Fundus photo, 1932x1910px, 45-degree field of view
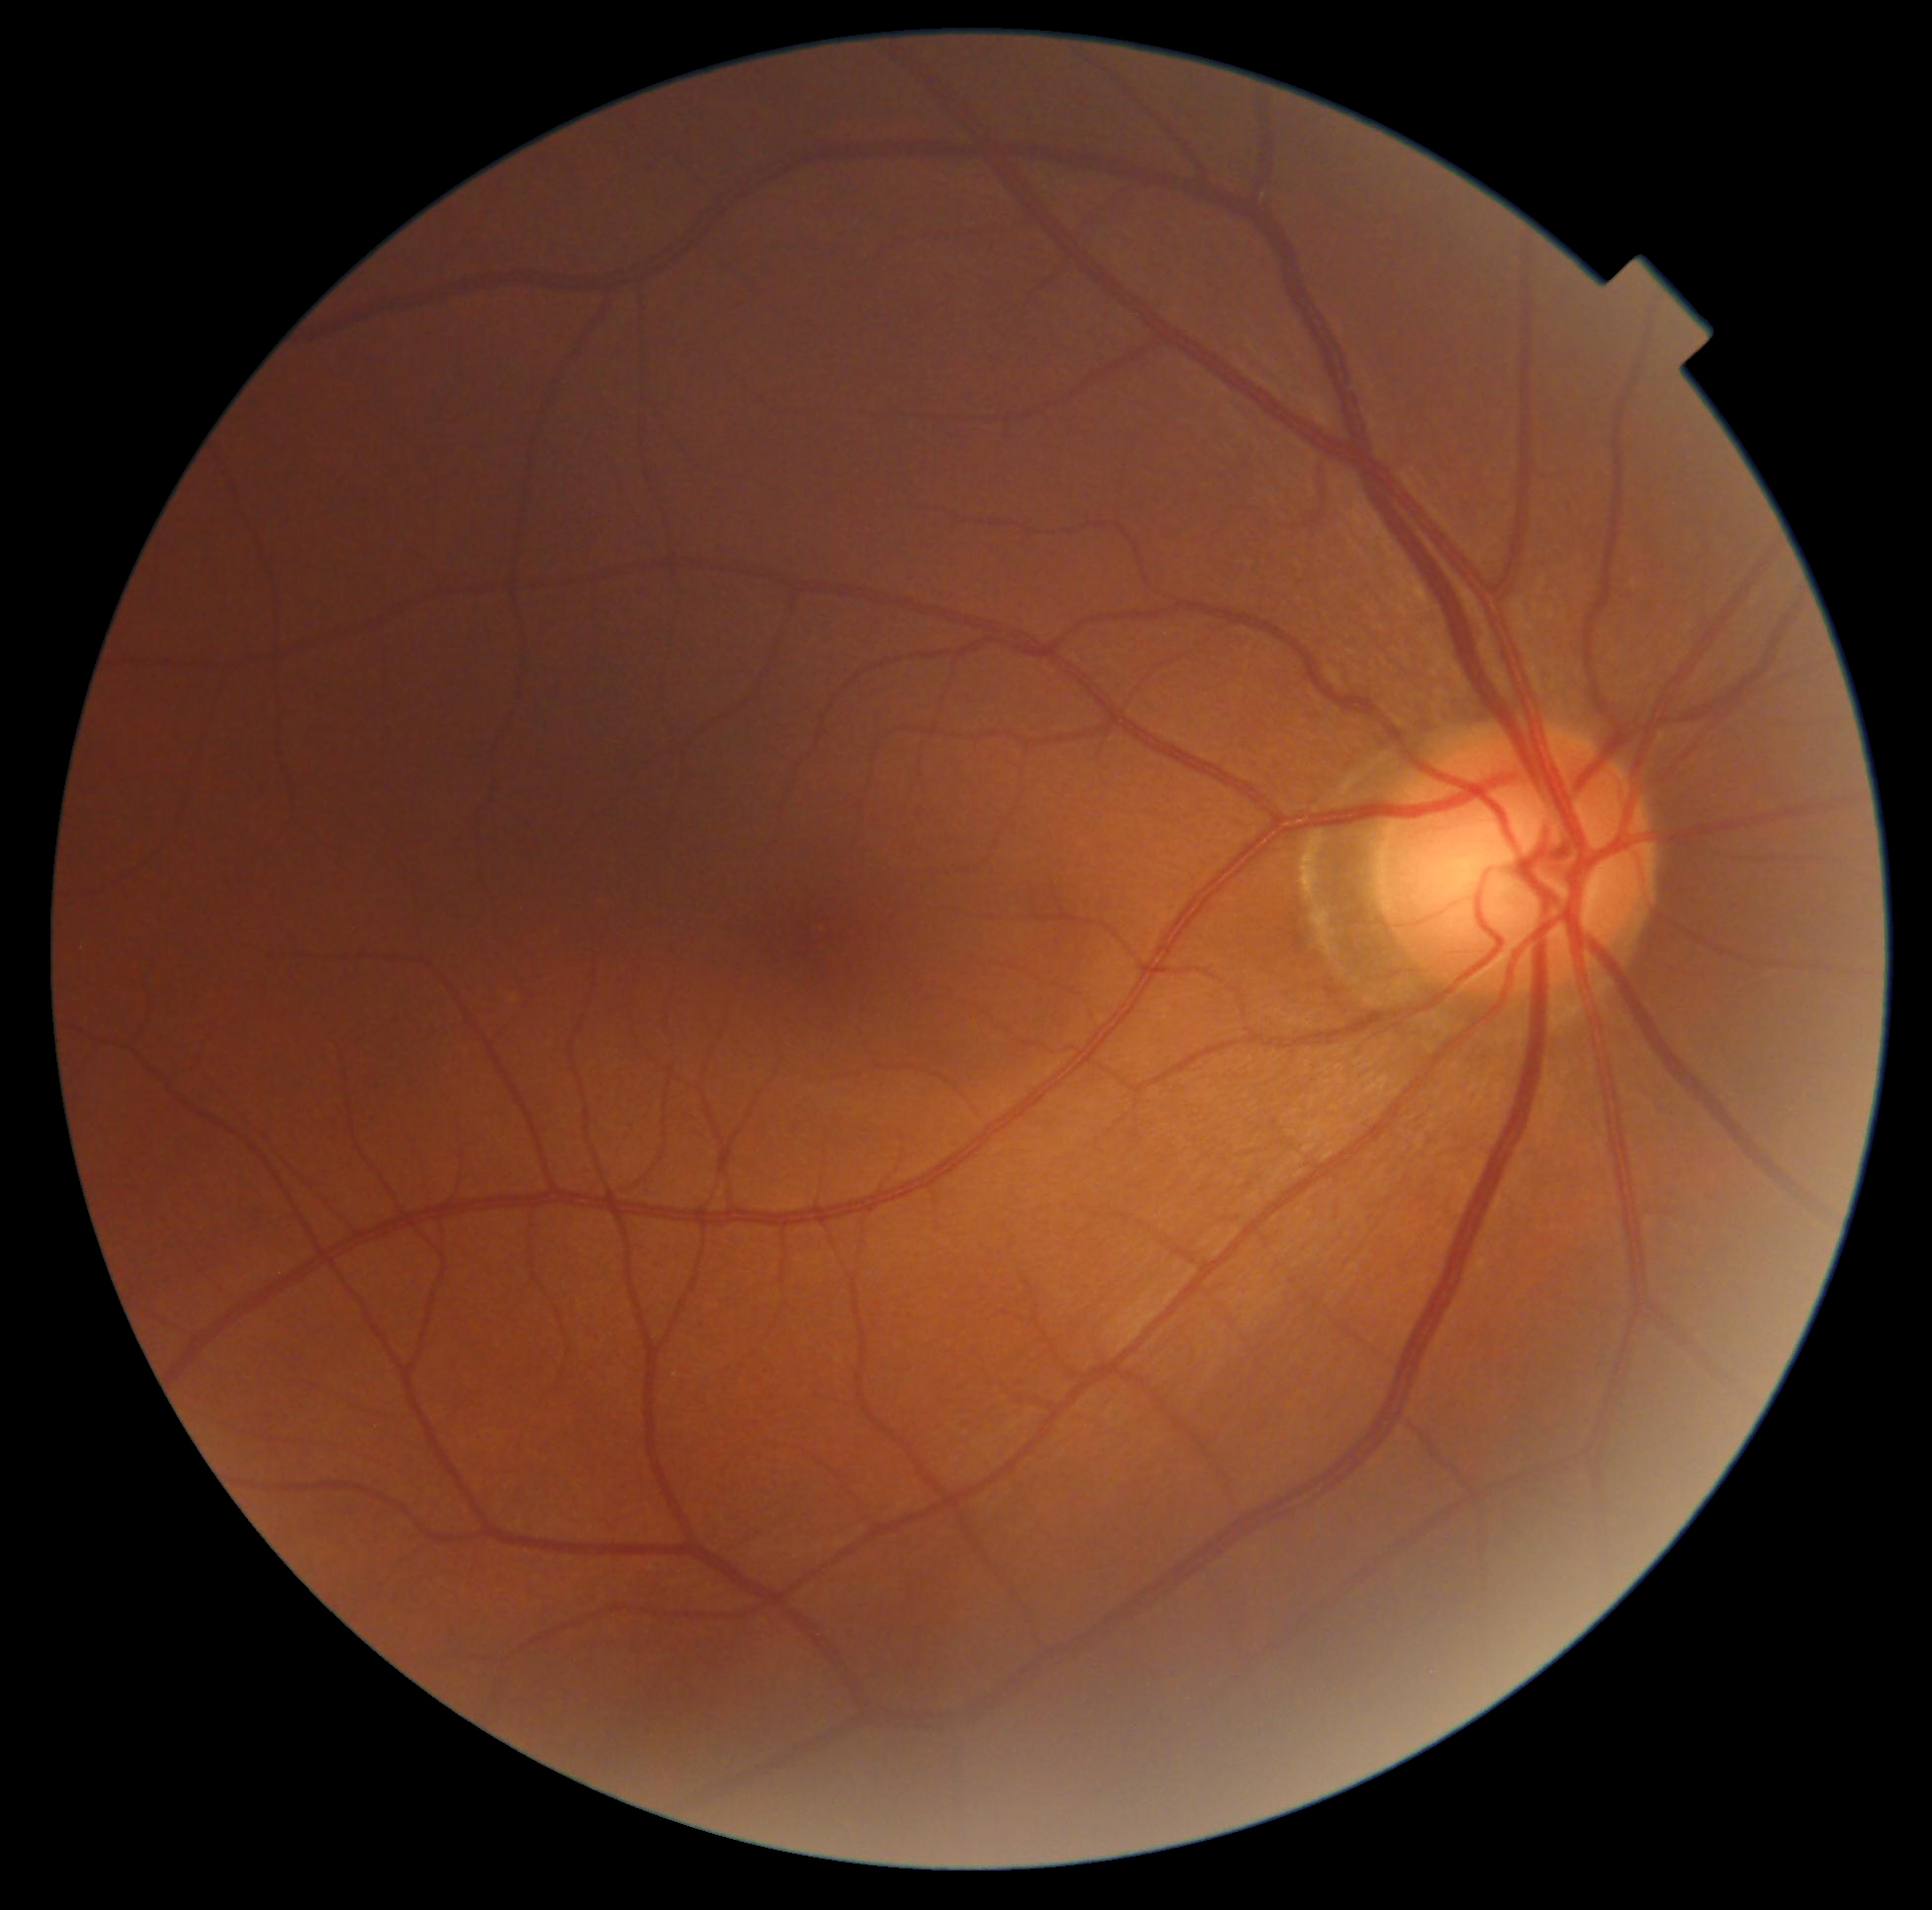 retinopathy grade = 0; DR impression = no DR findings.